Wide-field contact fundus photograph of an infant. Captured with the Natus RetCam Envision (130° field of view). 1440x1080 — 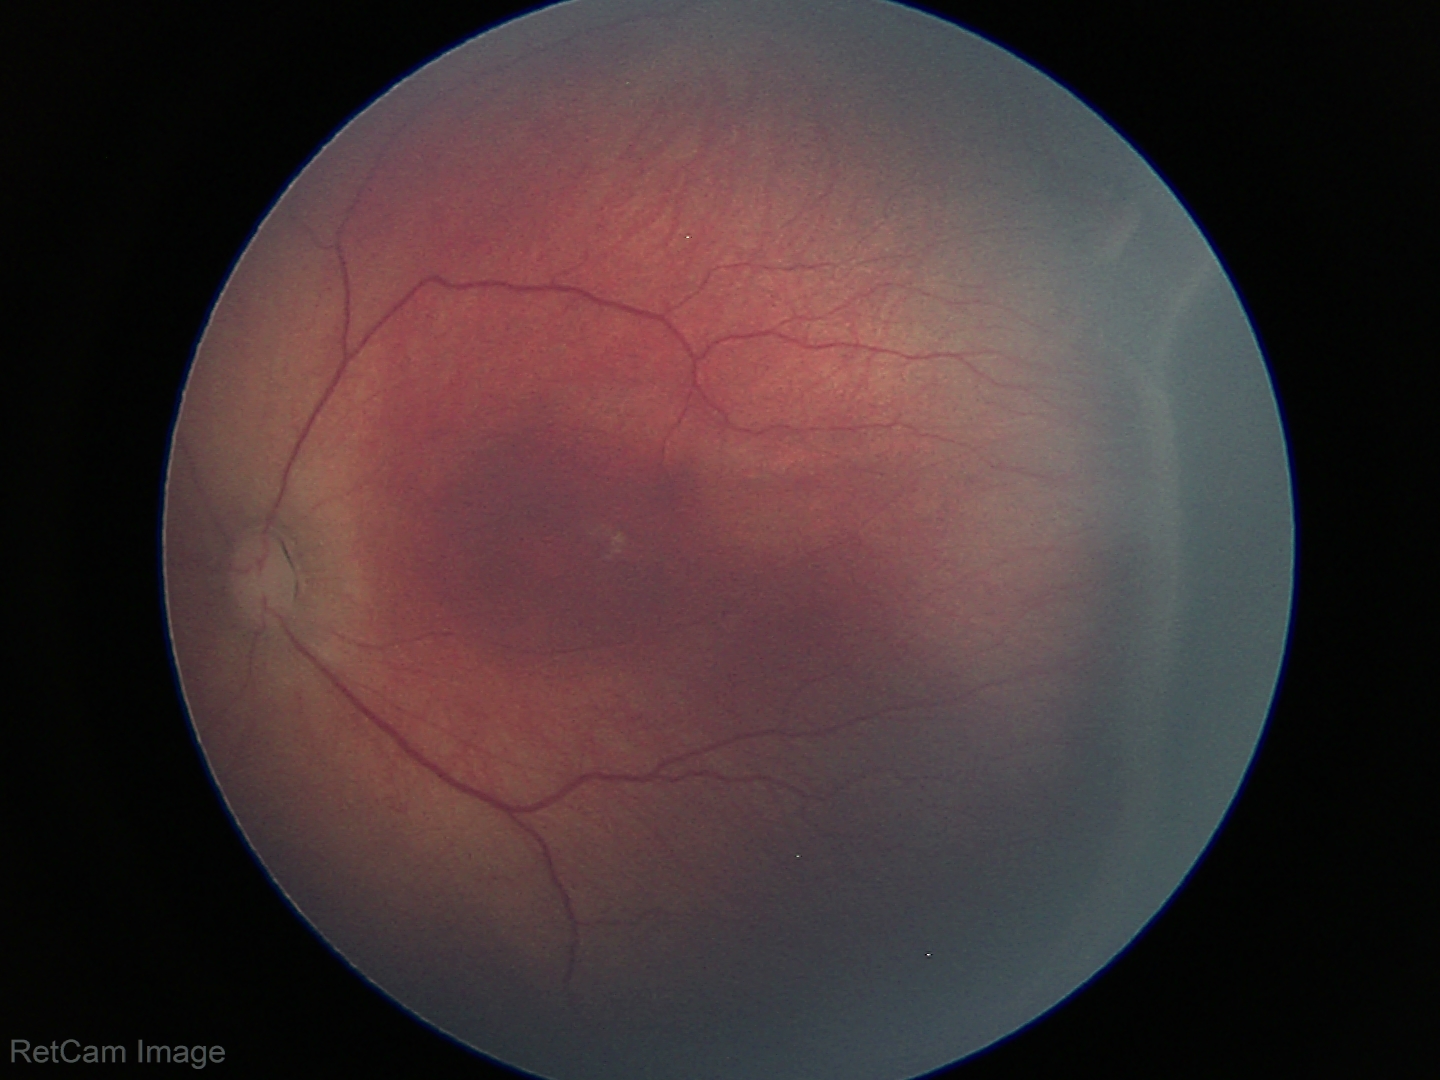 Without plus disease. Examination diagnosed as retinopathy of prematurity (ROP) stage 3.